45° field of view. NIDEK AFC-230. Nonmydriatic fundus photograph: 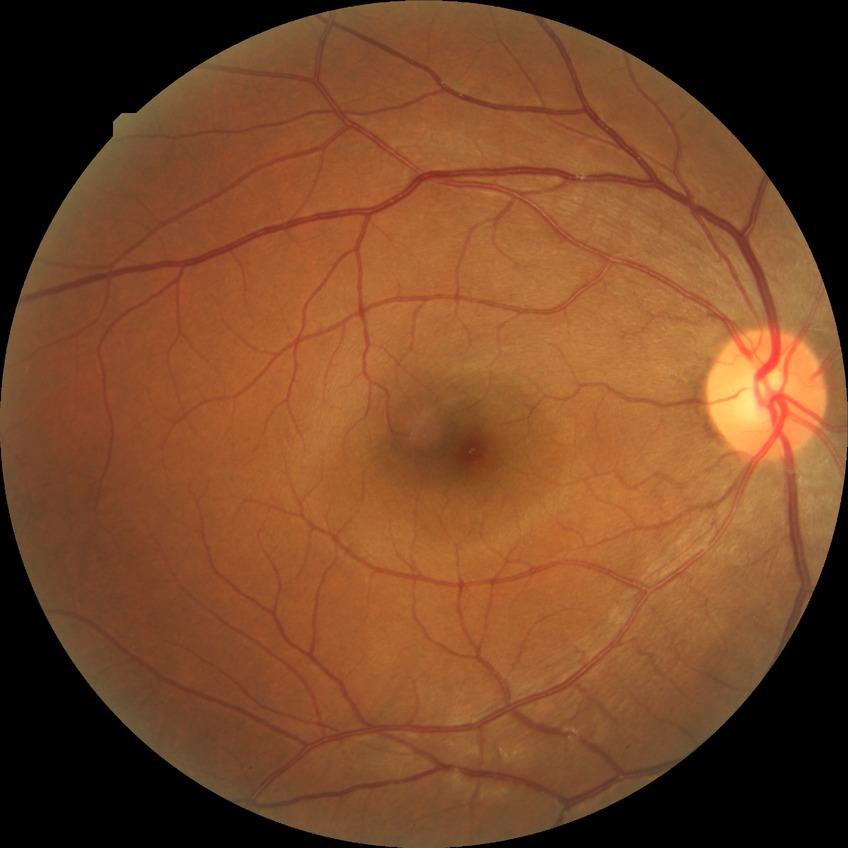 Diabetic retinopathy (DR): no diabetic retinopathy (NDR).